45-degree field of view
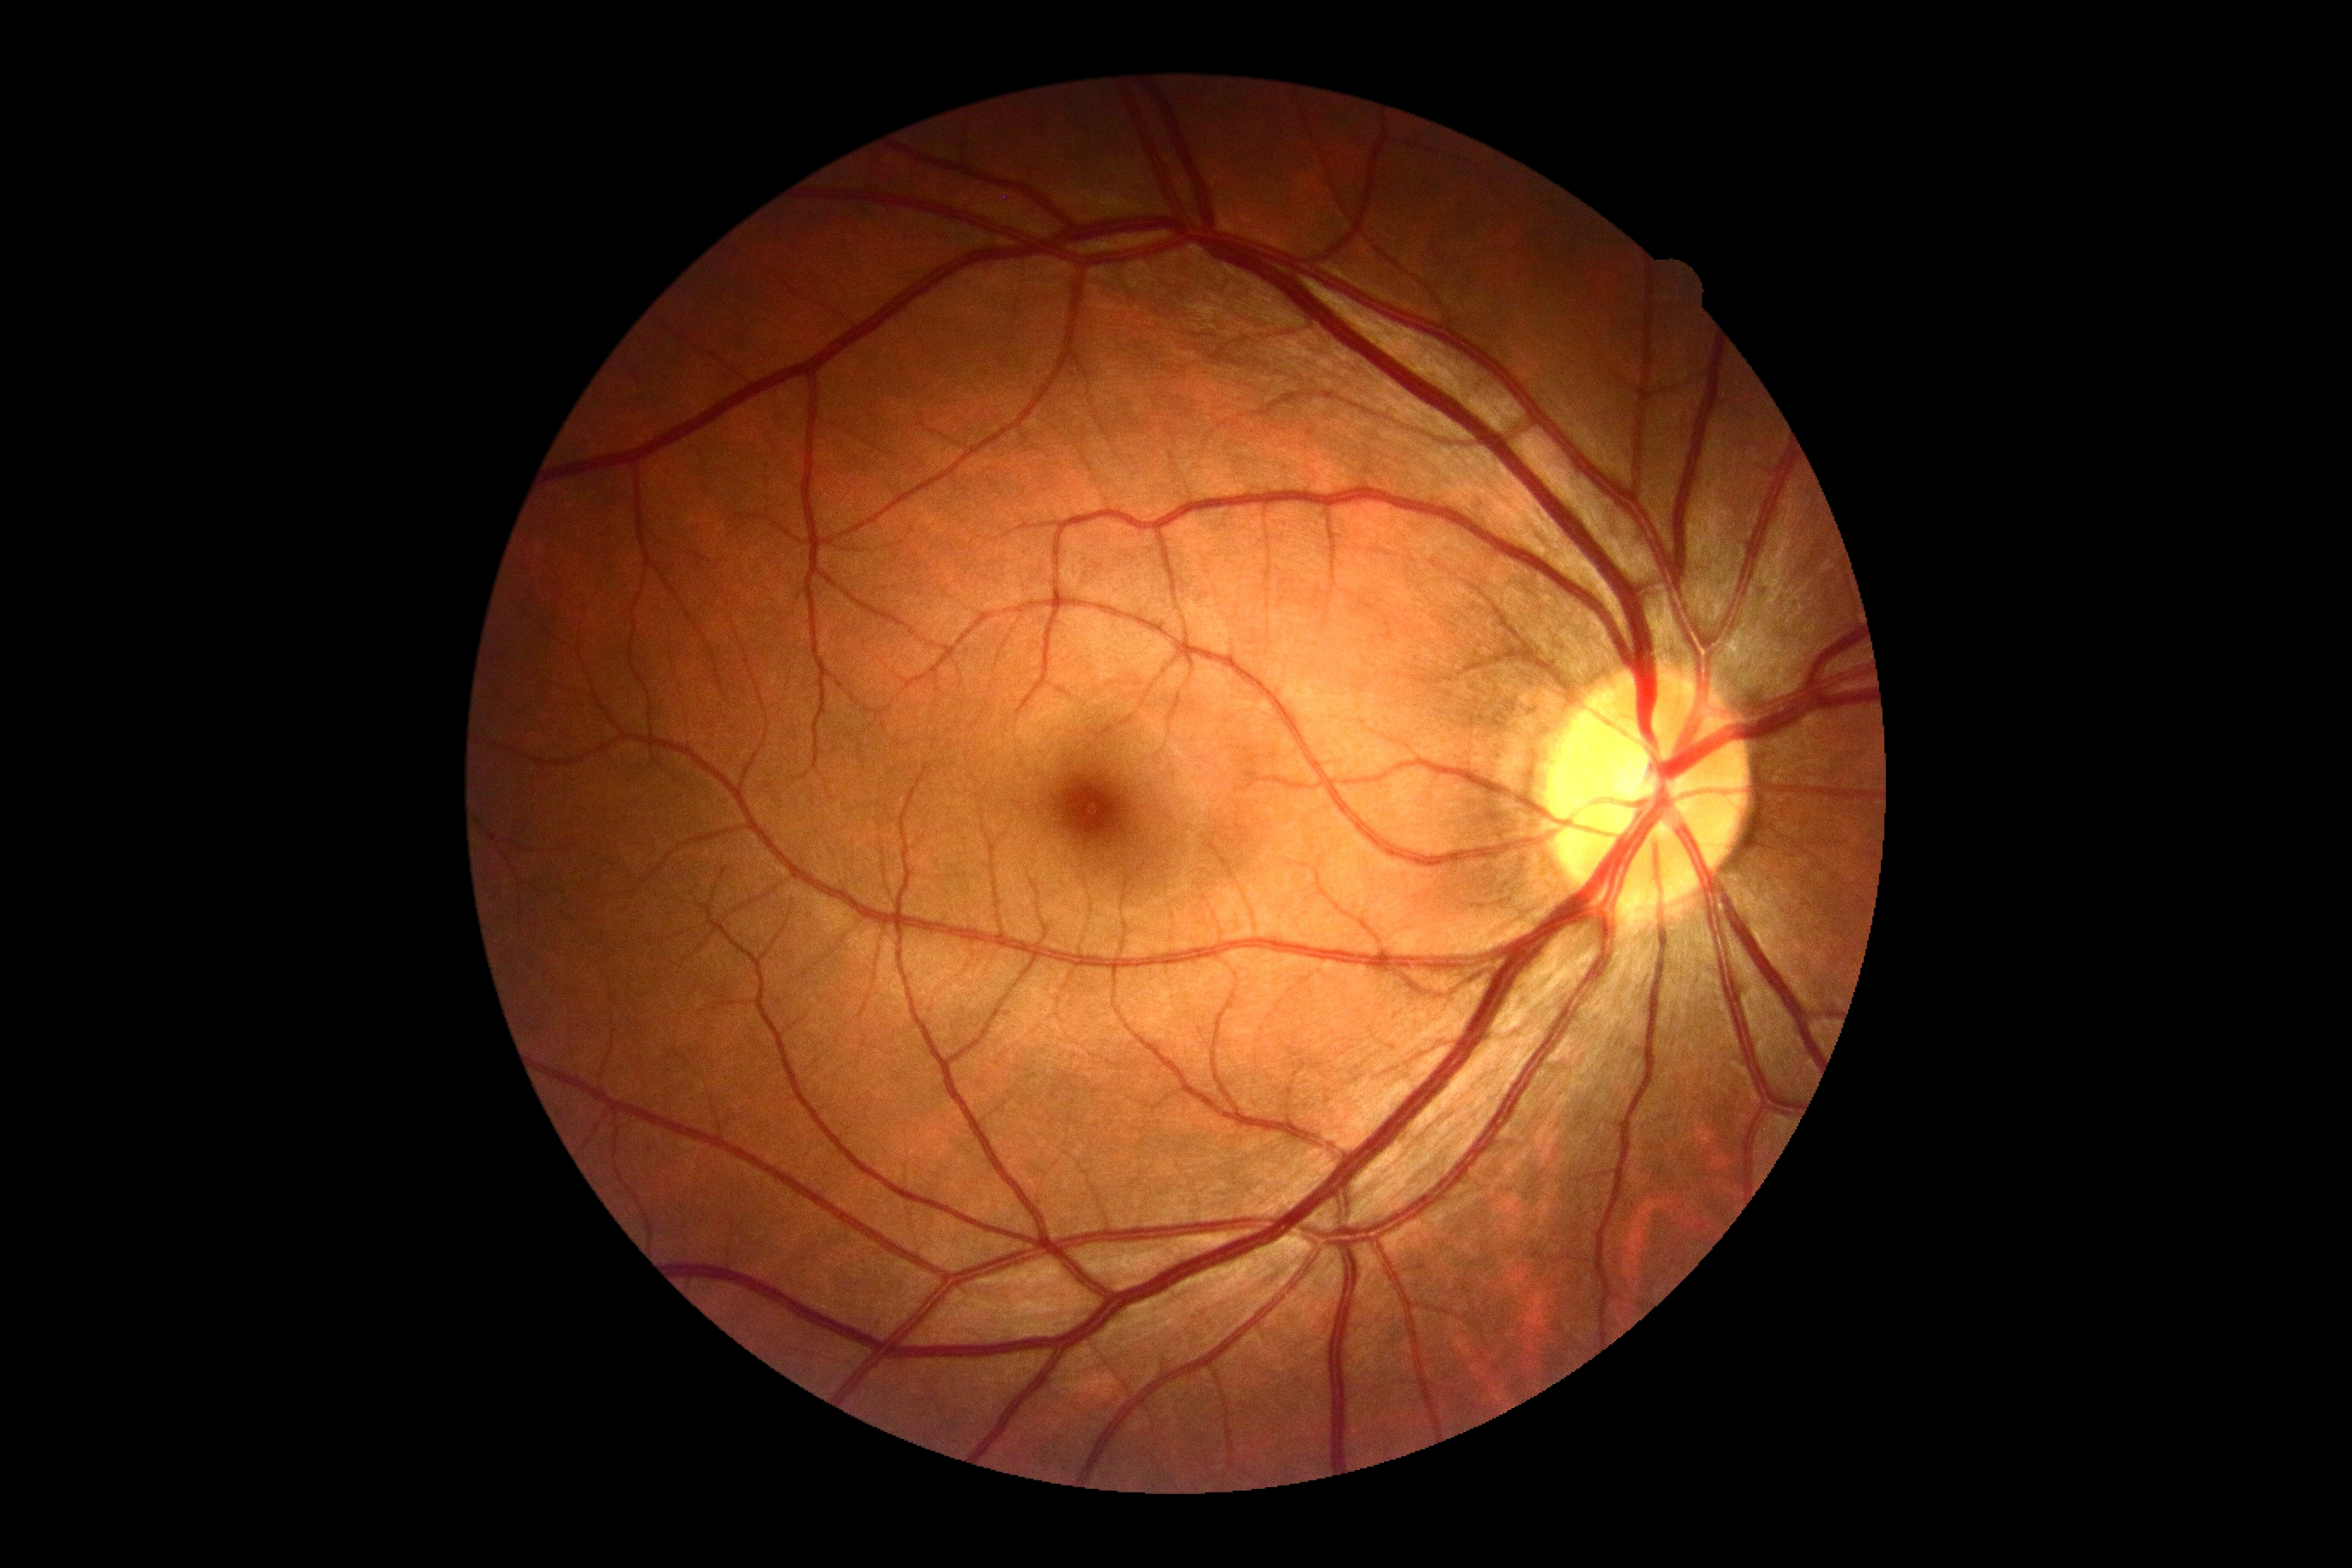
DR is grade 0 (no apparent retinopathy) — no visible signs of diabetic retinopathy.
No apparent diabetic retinopathy.